848x848; FOV: 45 degrees — 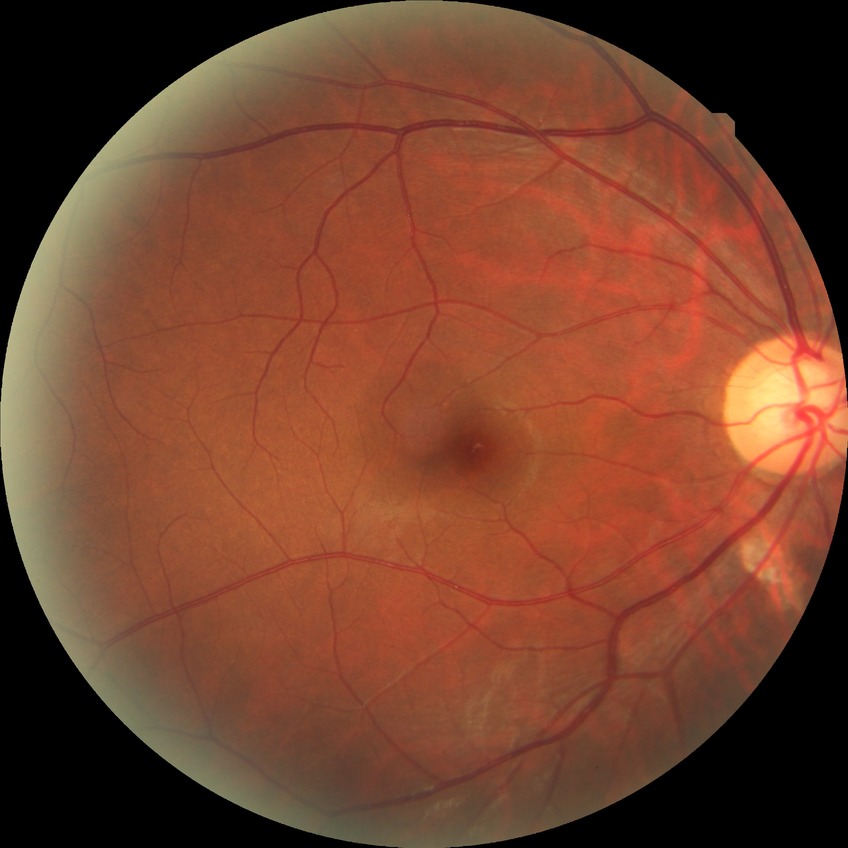

diabetic retinopathy (DR) = NDR (no diabetic retinopathy).